Fundus photo, without pupil dilation, graded on the modified Davis scale, 45° field of view — 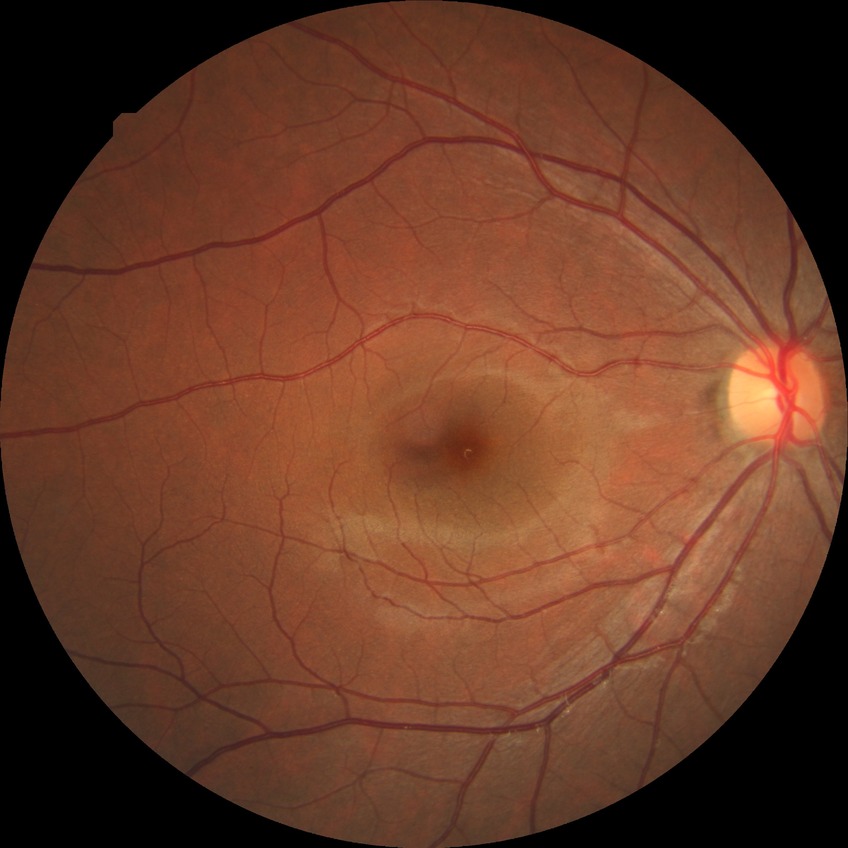

Diabetic retinopathy (DR): NDR (no diabetic retinopathy).